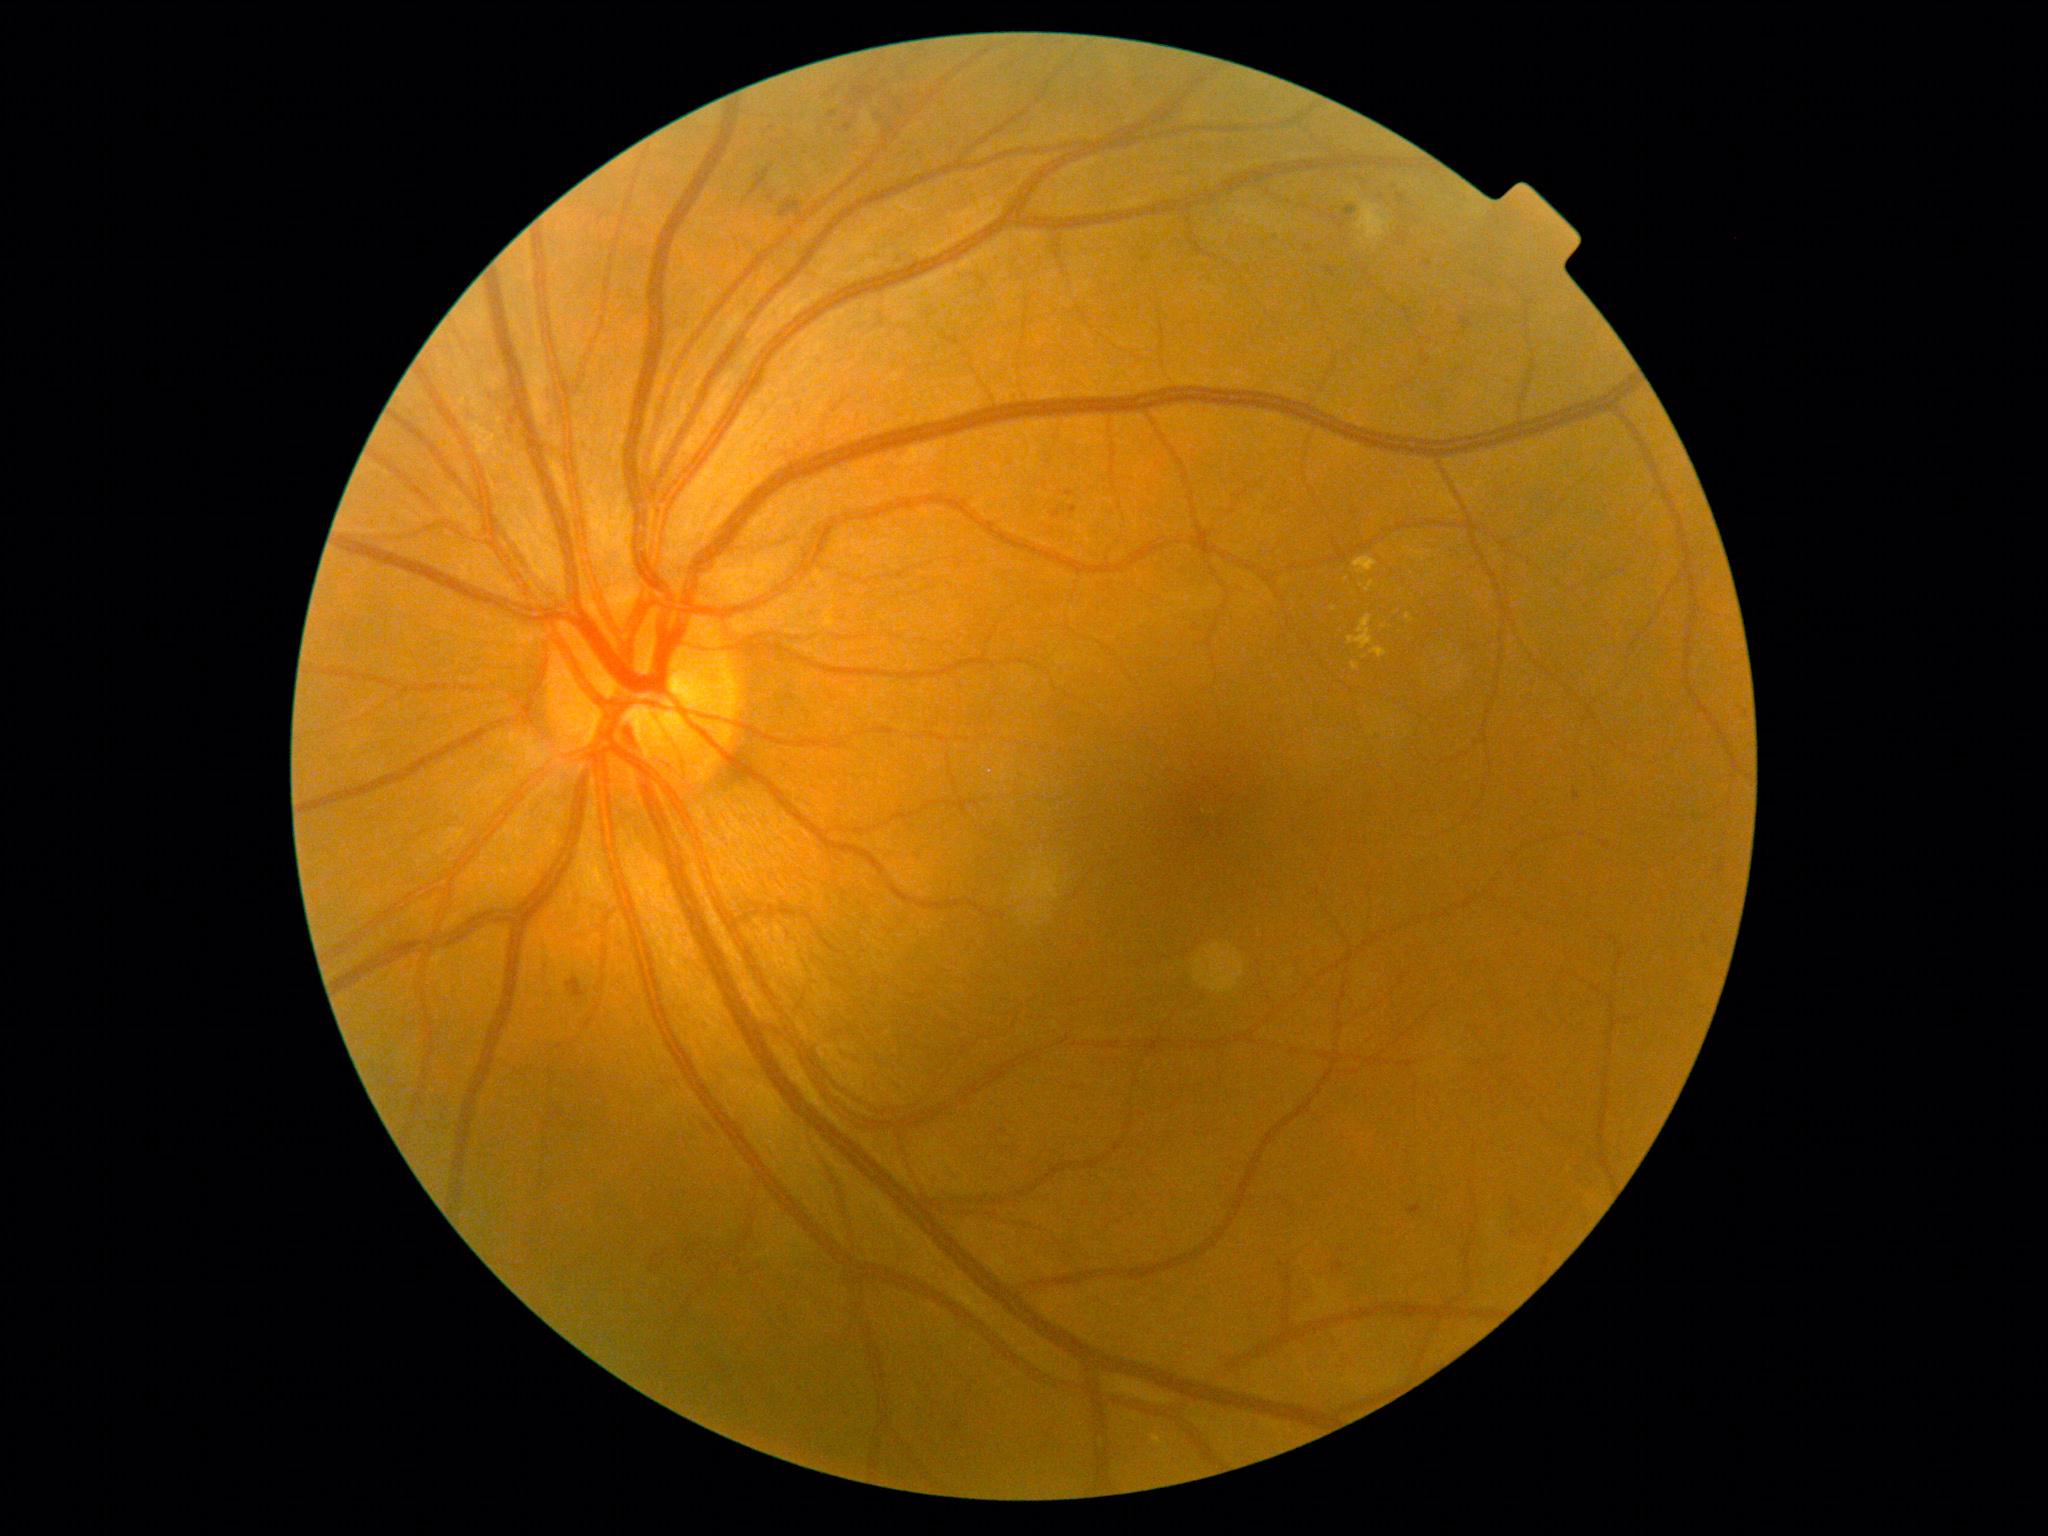

Diabetic retinopathy (DR): 2/4; non-proliferative diabetic retinopathy
A subset of detected lesions:
hemorrhages (HEs) (partial): bbox=[769, 195, 774, 204], bbox=[566, 978, 589, 1006], bbox=[651, 1249, 674, 1273], bbox=[686, 1244, 726, 1270], bbox=[853, 87, 876, 98], bbox=[749, 169, 770, 197], bbox=[780, 199, 803, 219]
Small HEs approximately at [804, 221], [860, 101]
microaneurysms (MAs) (partial): bbox=[1421, 263, 1431, 270], bbox=[952, 1424, 961, 1432], bbox=[1510, 1231, 1518, 1240], bbox=[995, 1128, 1007, 1135], bbox=[509, 417, 516, 426], bbox=[1305, 247, 1314, 253], bbox=[1333, 1261, 1344, 1274], bbox=[1051, 508, 1061, 519], bbox=[1460, 317, 1473, 330], bbox=[1066, 491, 1074, 498]
Small MAs approximately at [1342, 1251]
soft exudates (SEs): bbox=[1357, 202, 1390, 242], bbox=[862, 112, 878, 139]
hard exudates (EXs): bbox=[1348, 615, 1374, 650], bbox=[1371, 648, 1387, 659], bbox=[1366, 581, 1374, 593], bbox=[1152, 1436, 1163, 1446], bbox=[1354, 558, 1378, 575], bbox=[1406, 614, 1414, 624], bbox=[1353, 663, 1360, 671]
Small EXs approximately at [1384, 628], [1419, 553], [1362, 586], [1365, 658], [1346, 579], [1334, 610]